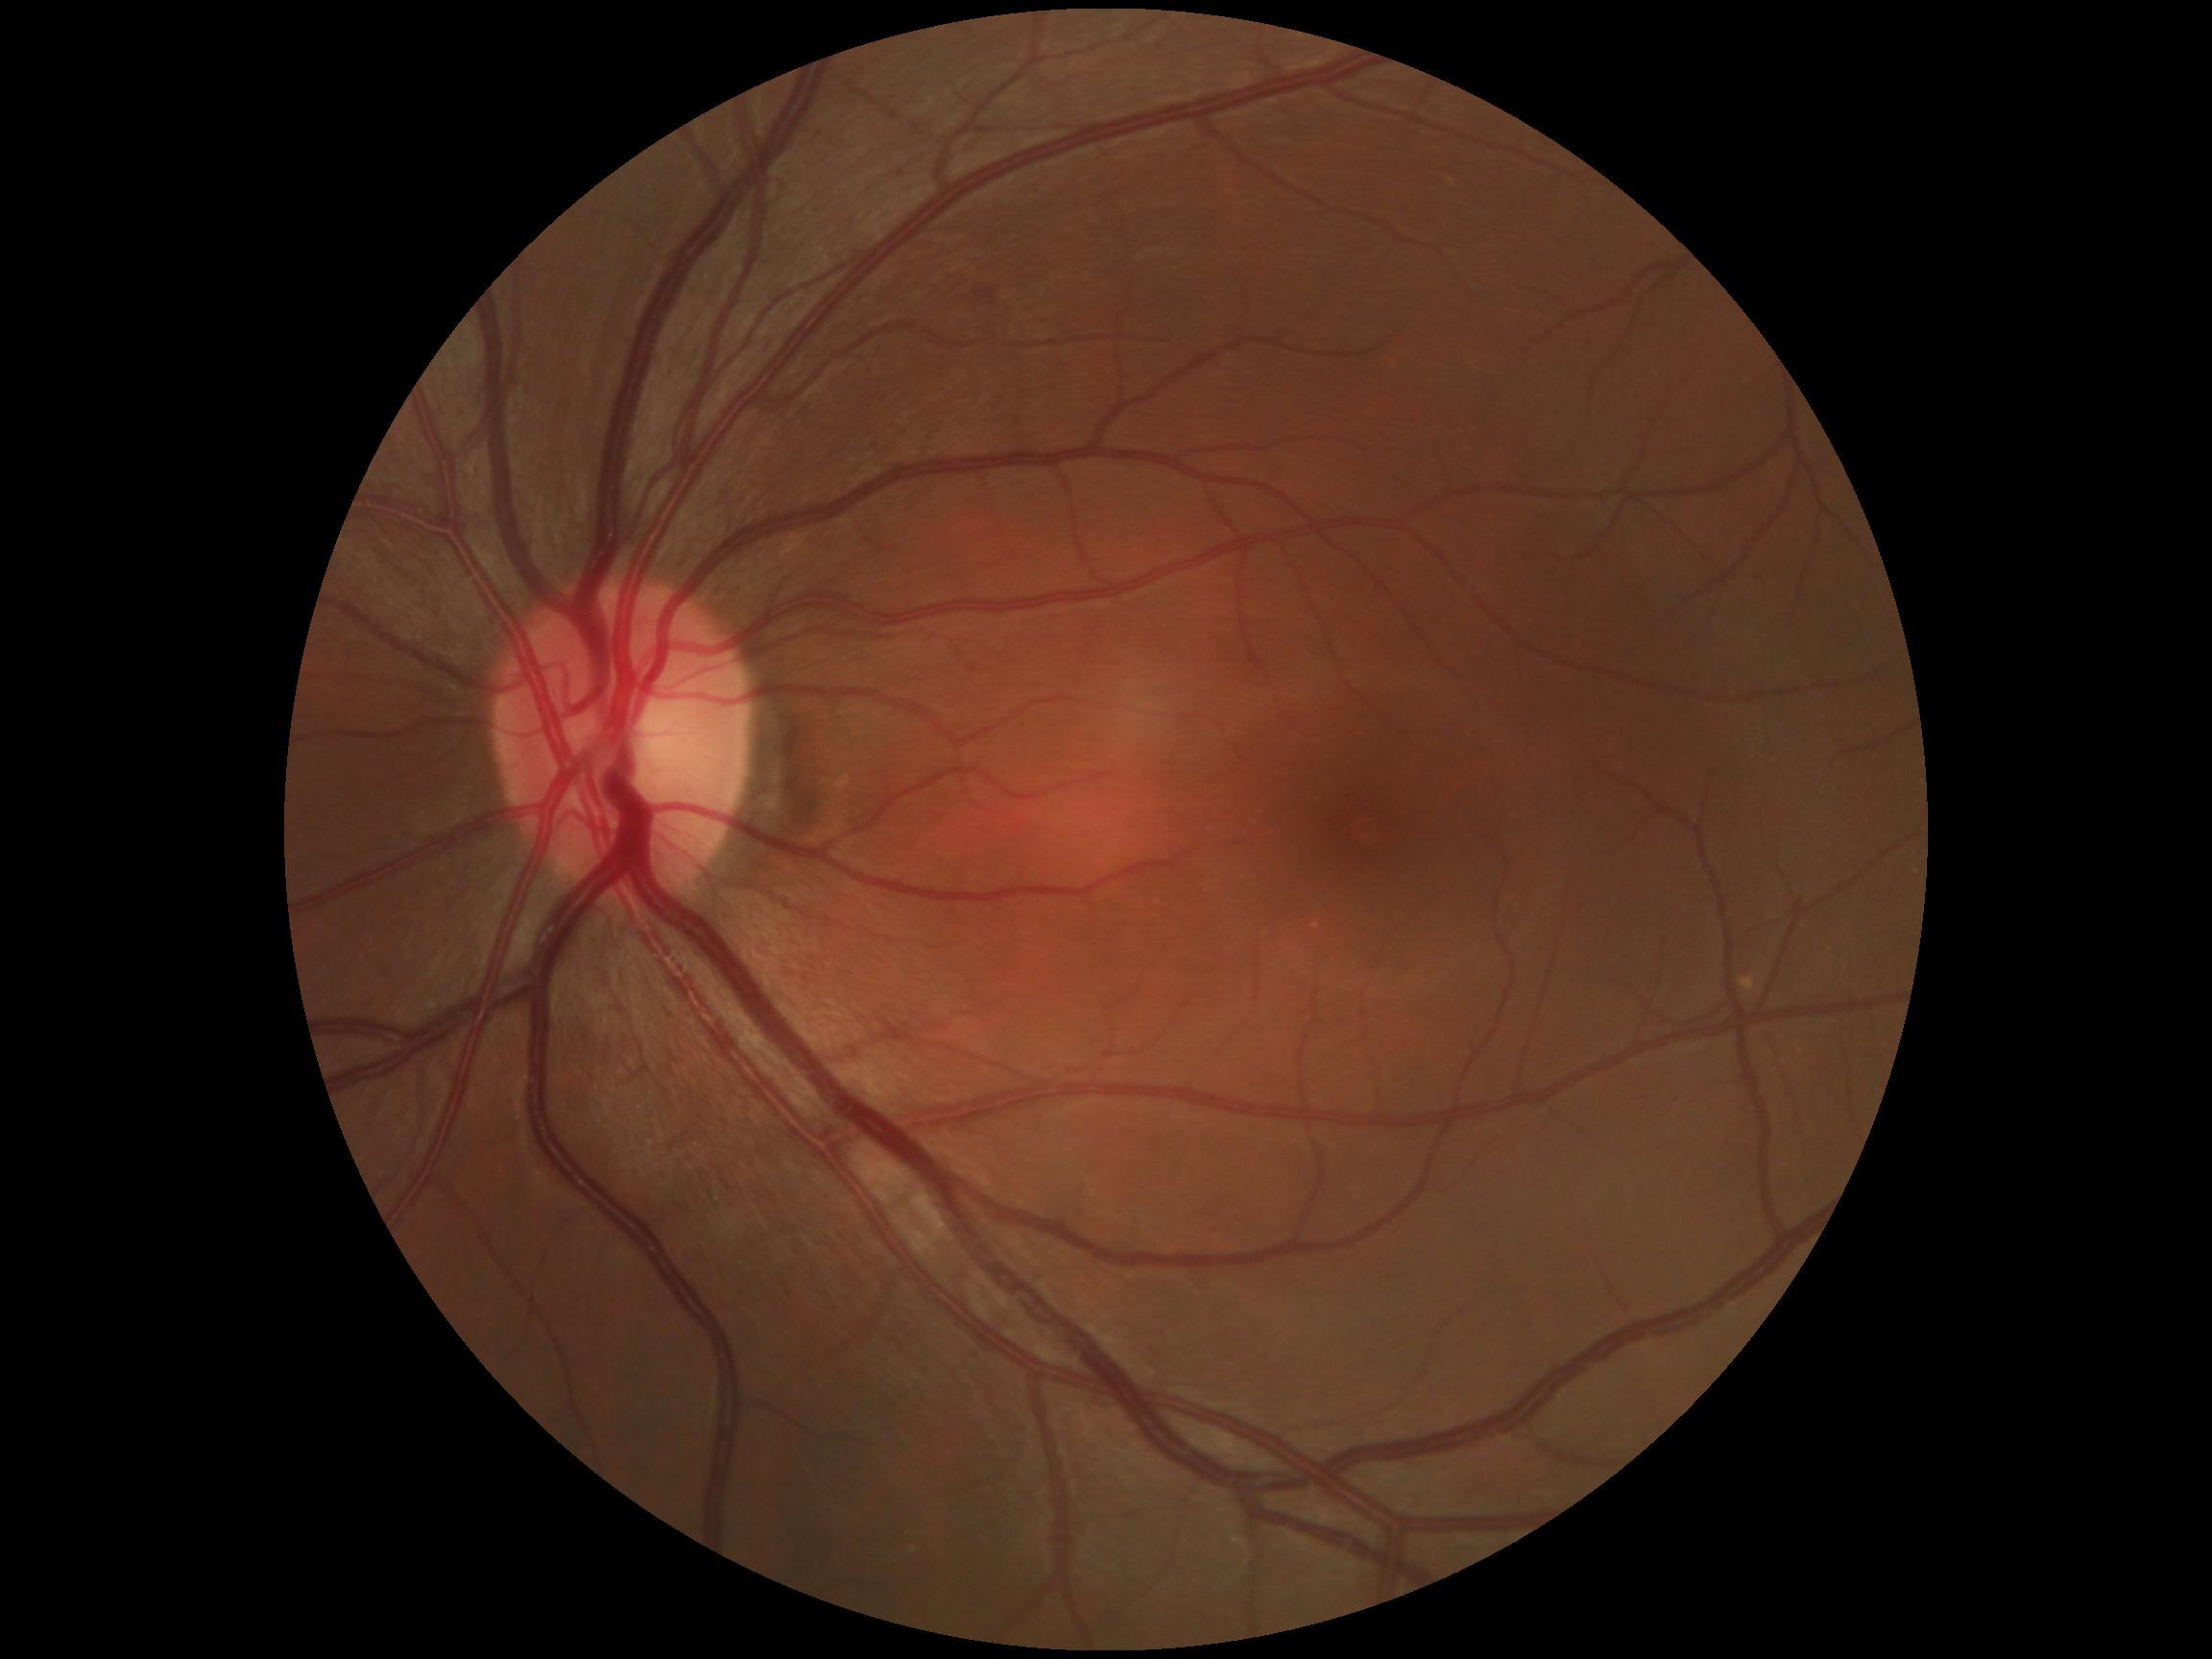 diabetic retinopathy (DR): grade 2 (moderate NPDR).